FOV: 45 degrees. 848 x 848 pixels:
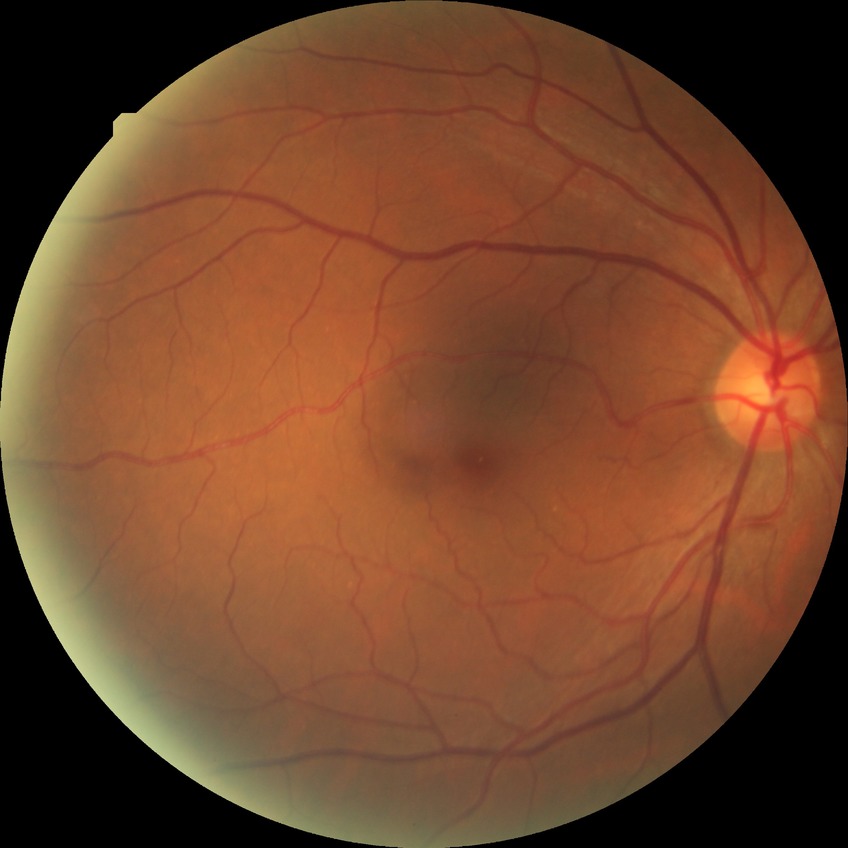 retinopathy grade@no diabetic retinopathy.